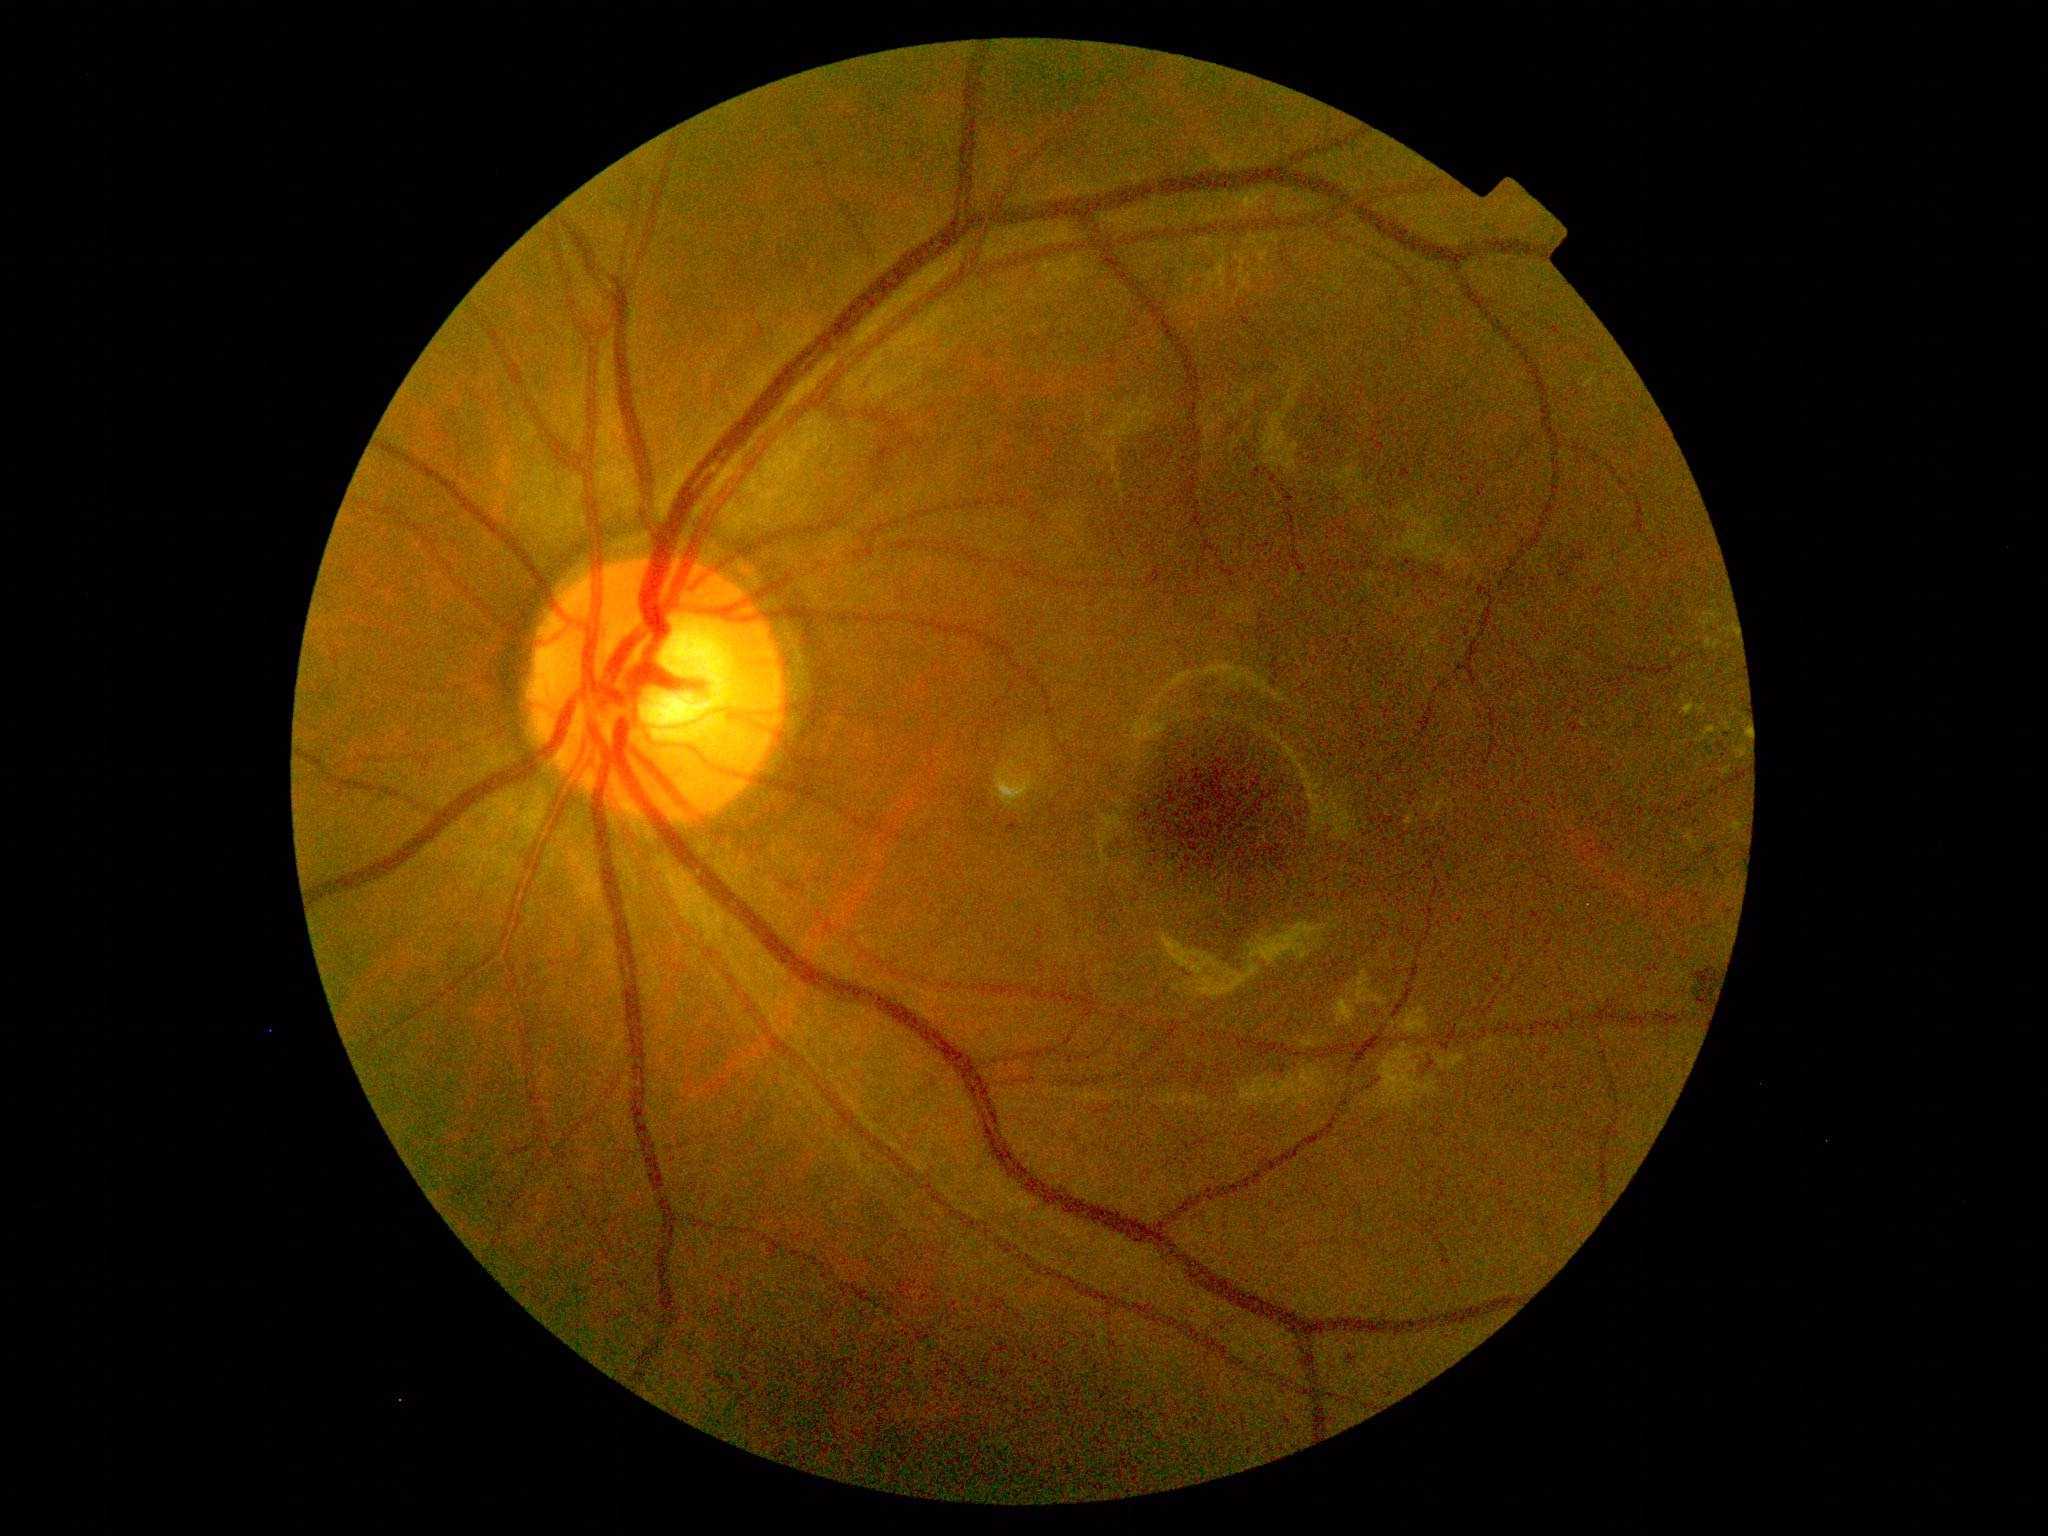

Diabetic retinopathy severity: grade 2.